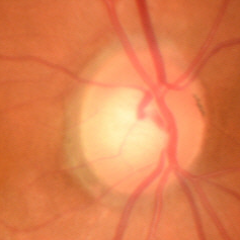 Q: Is glaucoma present?
A: No — no signs of glaucoma.